Image size 2212x1659:
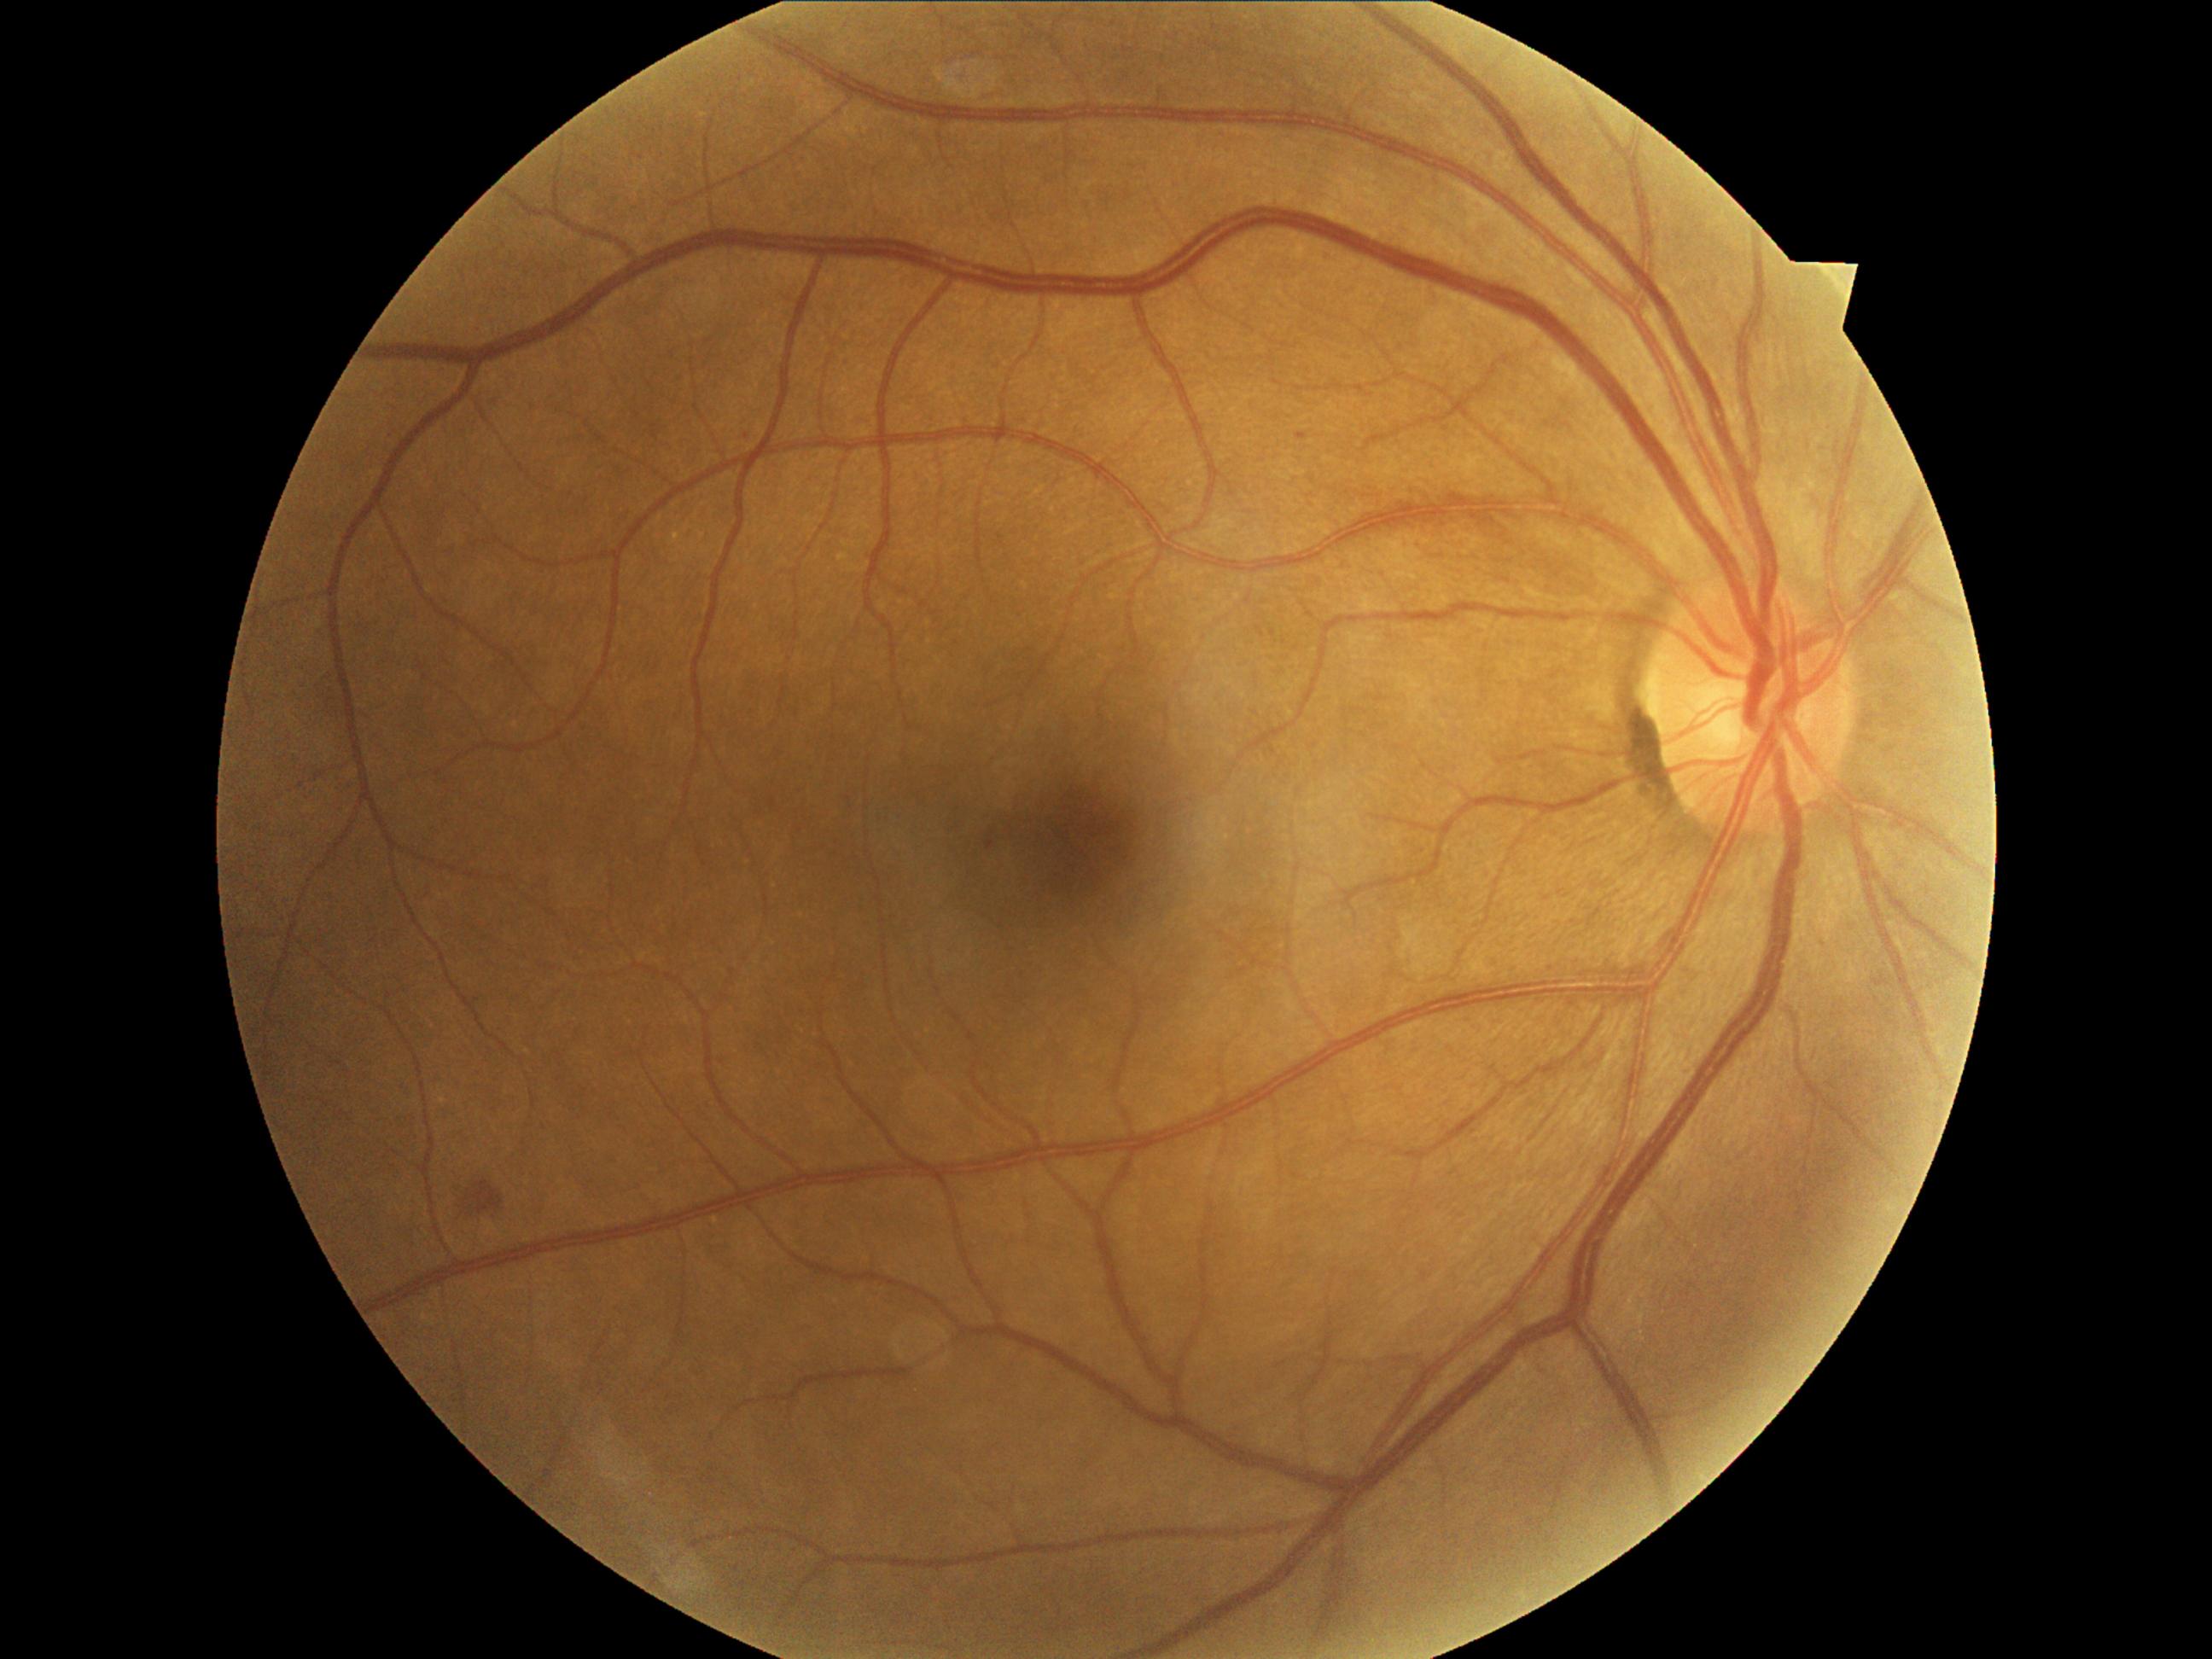 DR stage is grade 2.